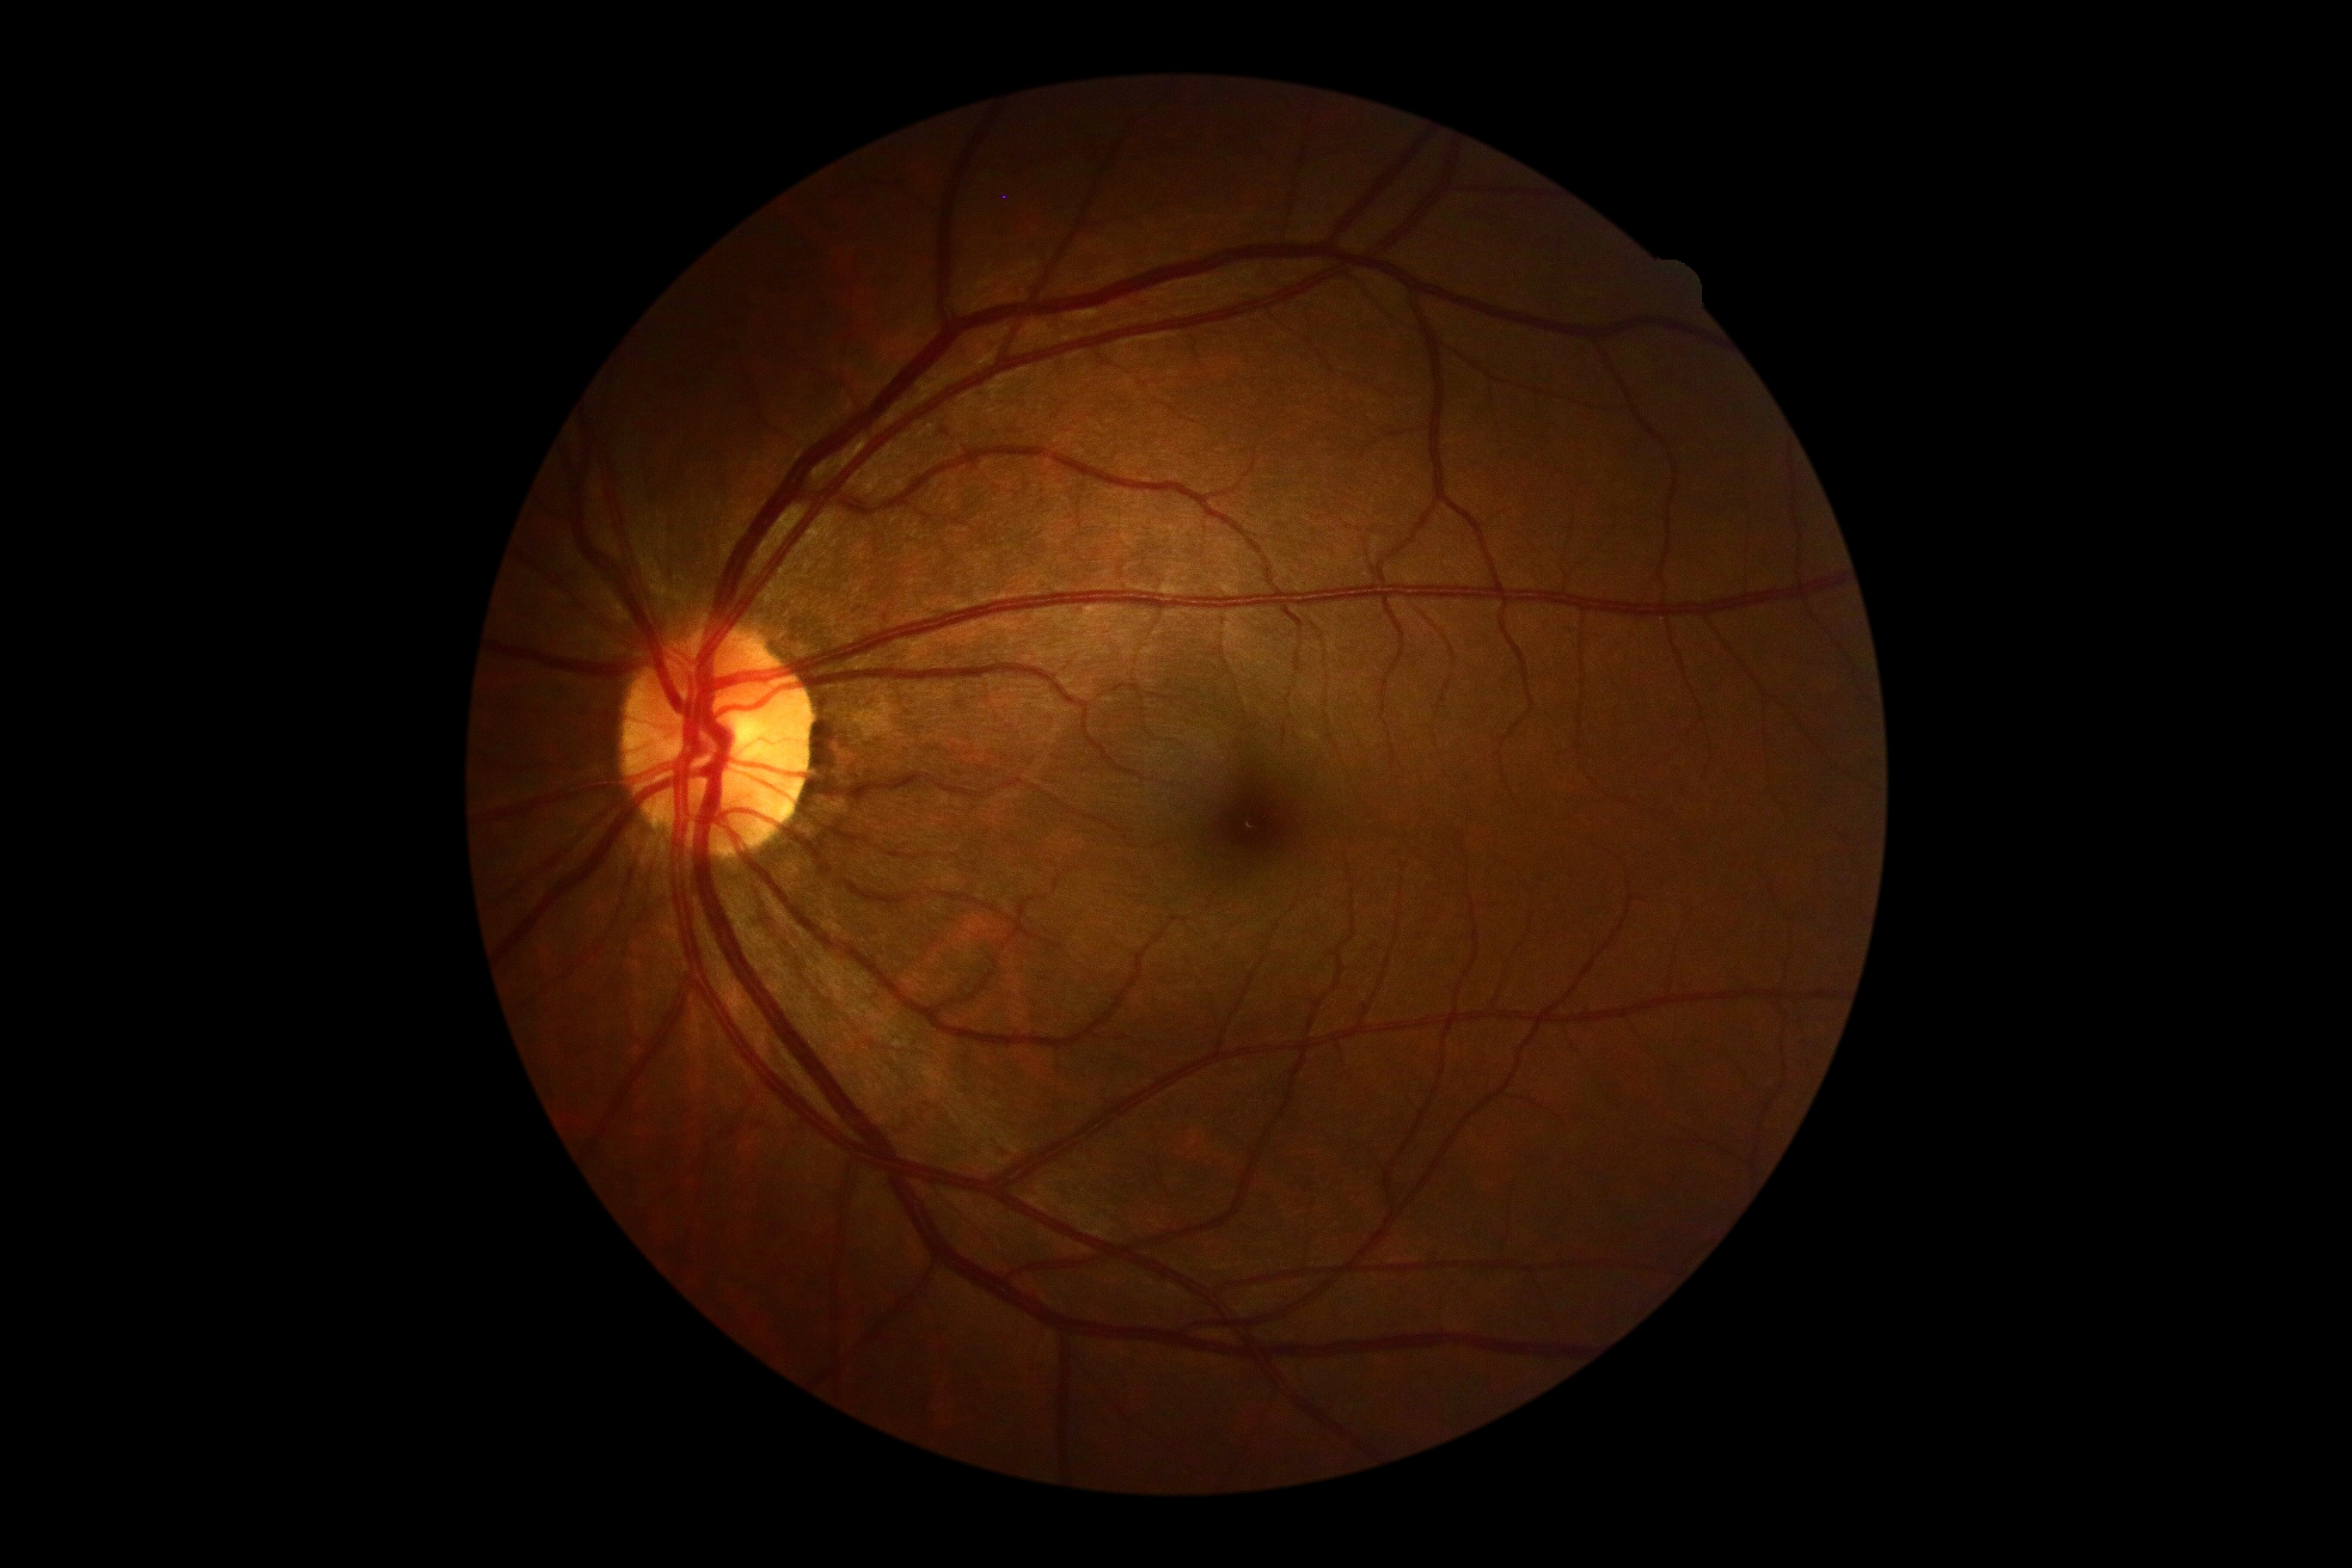
diabetic retinopathy grade@0 (no apparent retinopathy) — no visible signs of diabetic retinopathy.